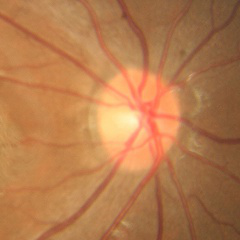
No glaucoma.